Davis DR grading; nonmydriatic fundus photograph; 848 by 848 pixels; 45° FOV: 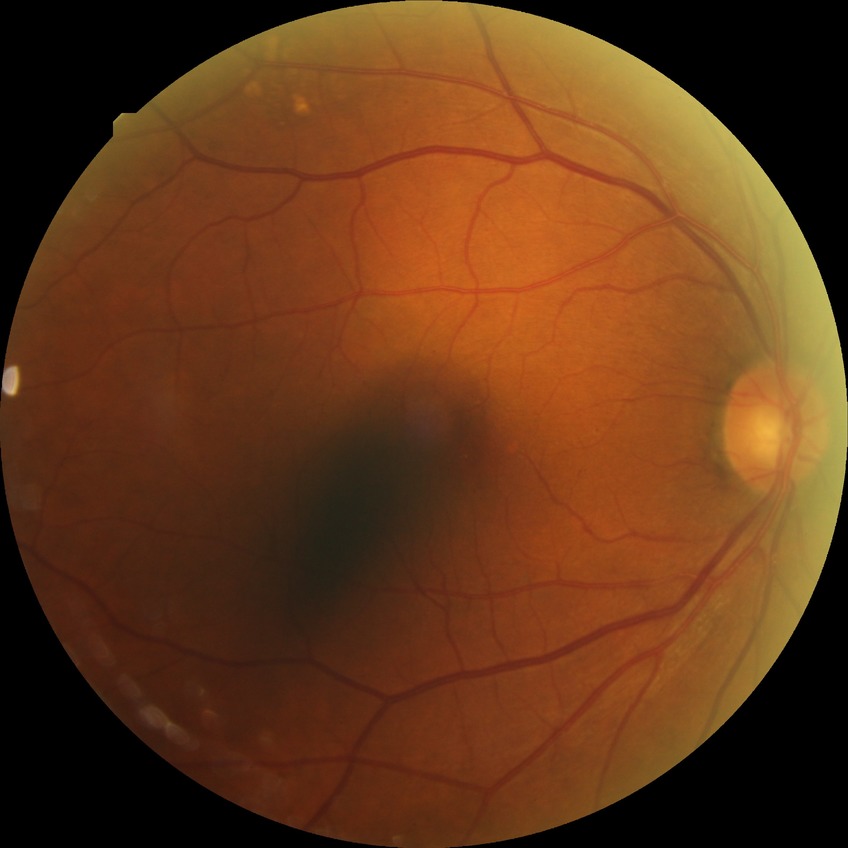

diabetic retinopathy stage@simple diabetic retinopathy.